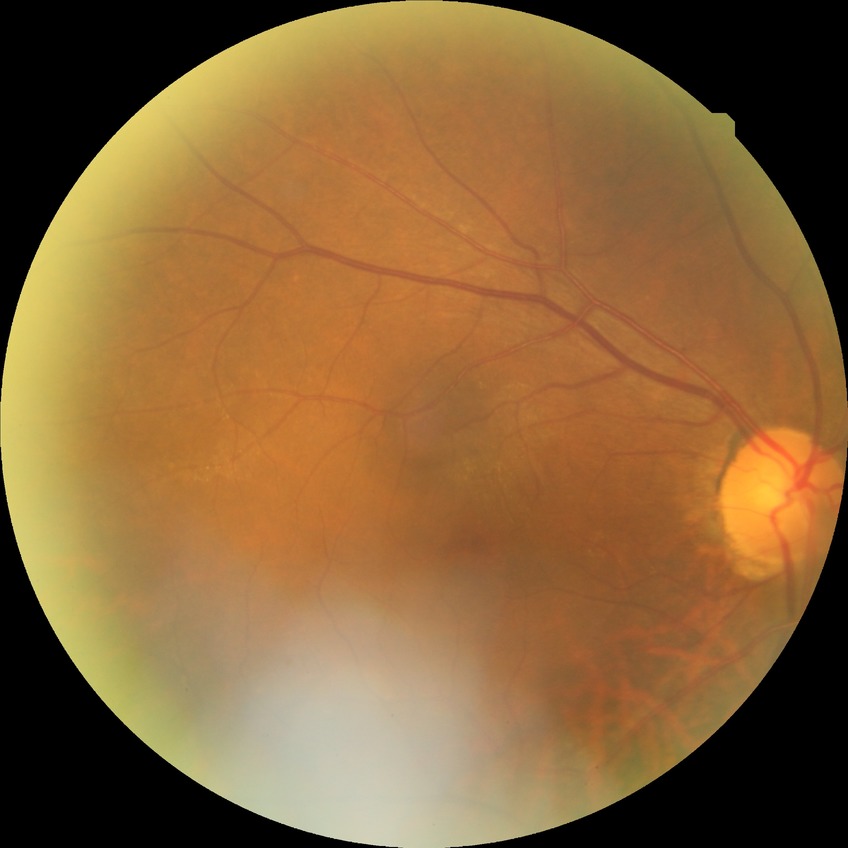

DR: NDR.